848x848px; CFP:
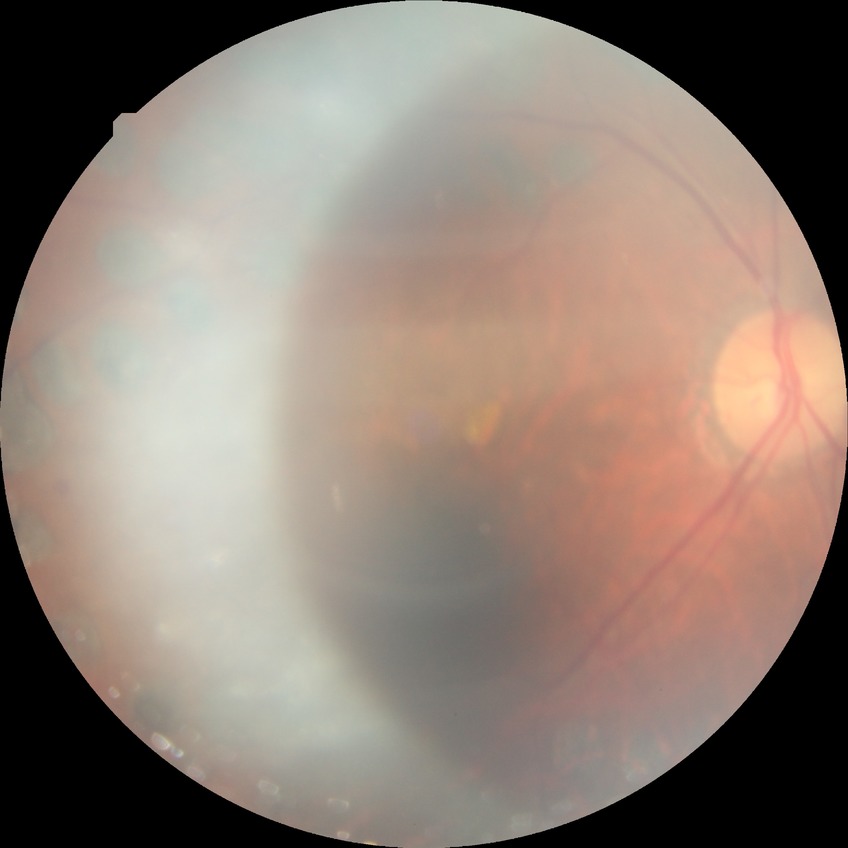 Diabetic retinopathy grade: proliferative diabetic retinopathy.